Color fundus photograph: 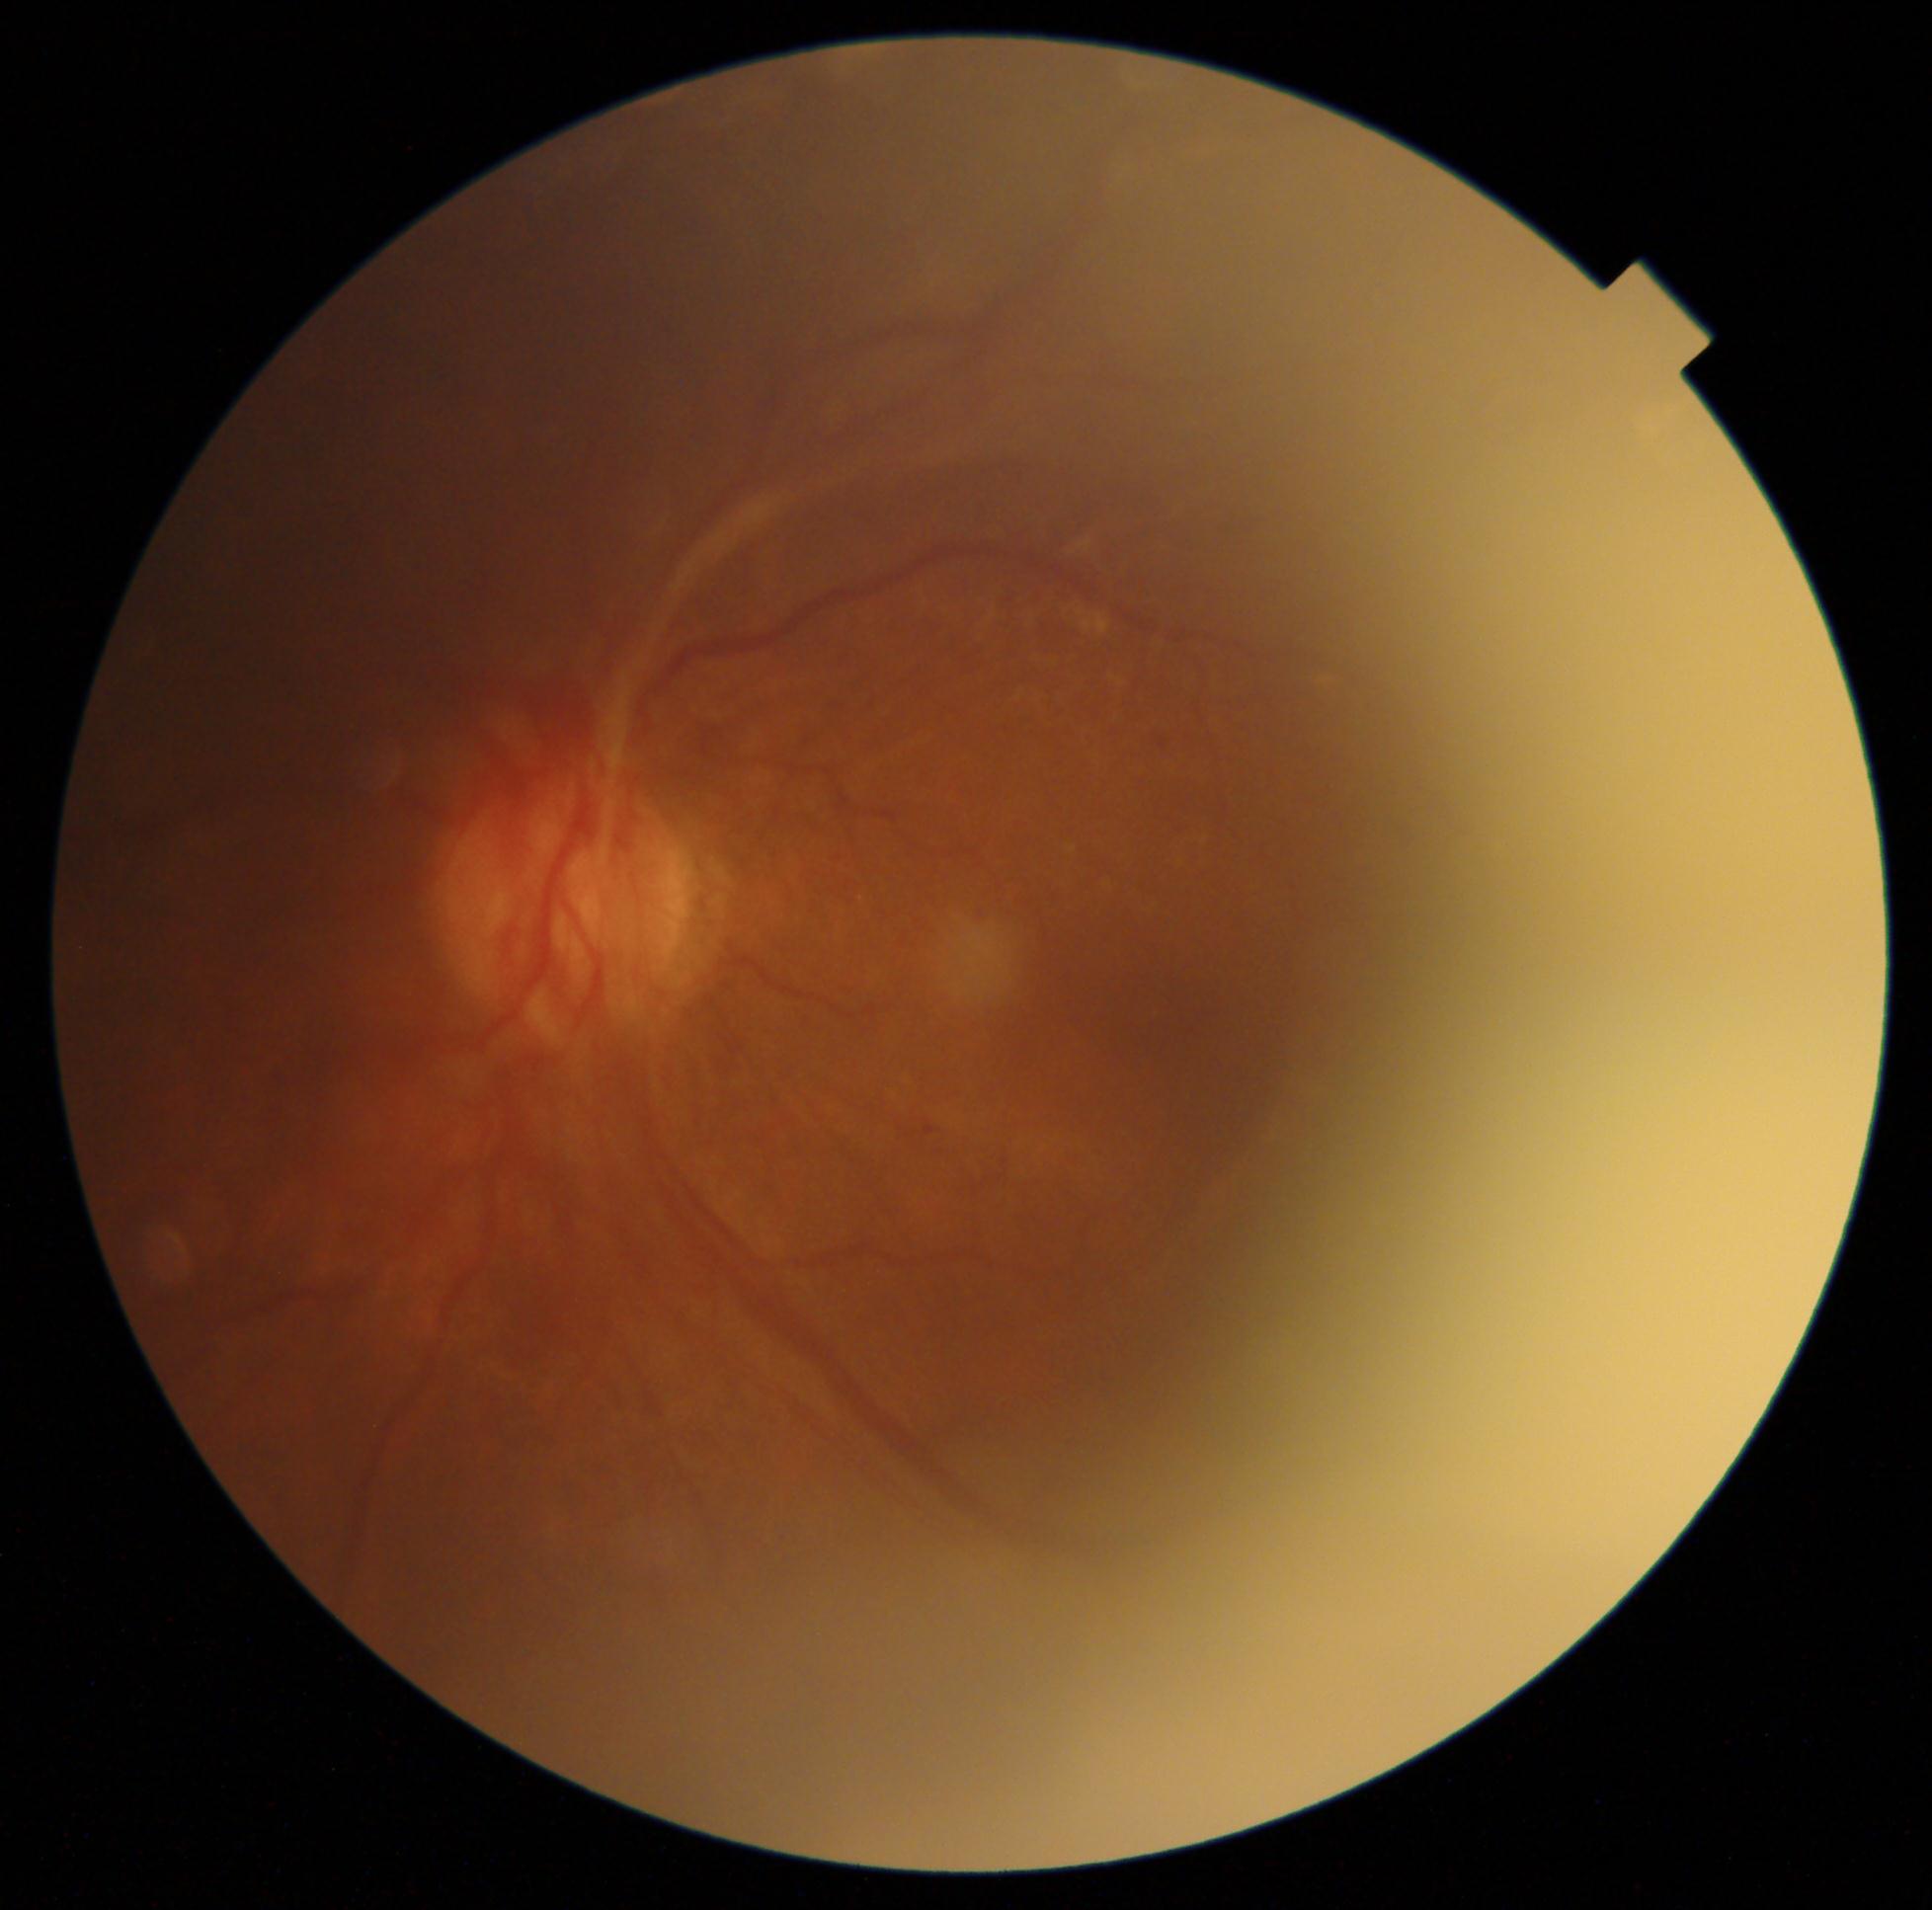

The retinopathy is classified as proliferative diabetic retinopathy. DR is grade 4.